Captured on a Remidio smartphone fundus camera
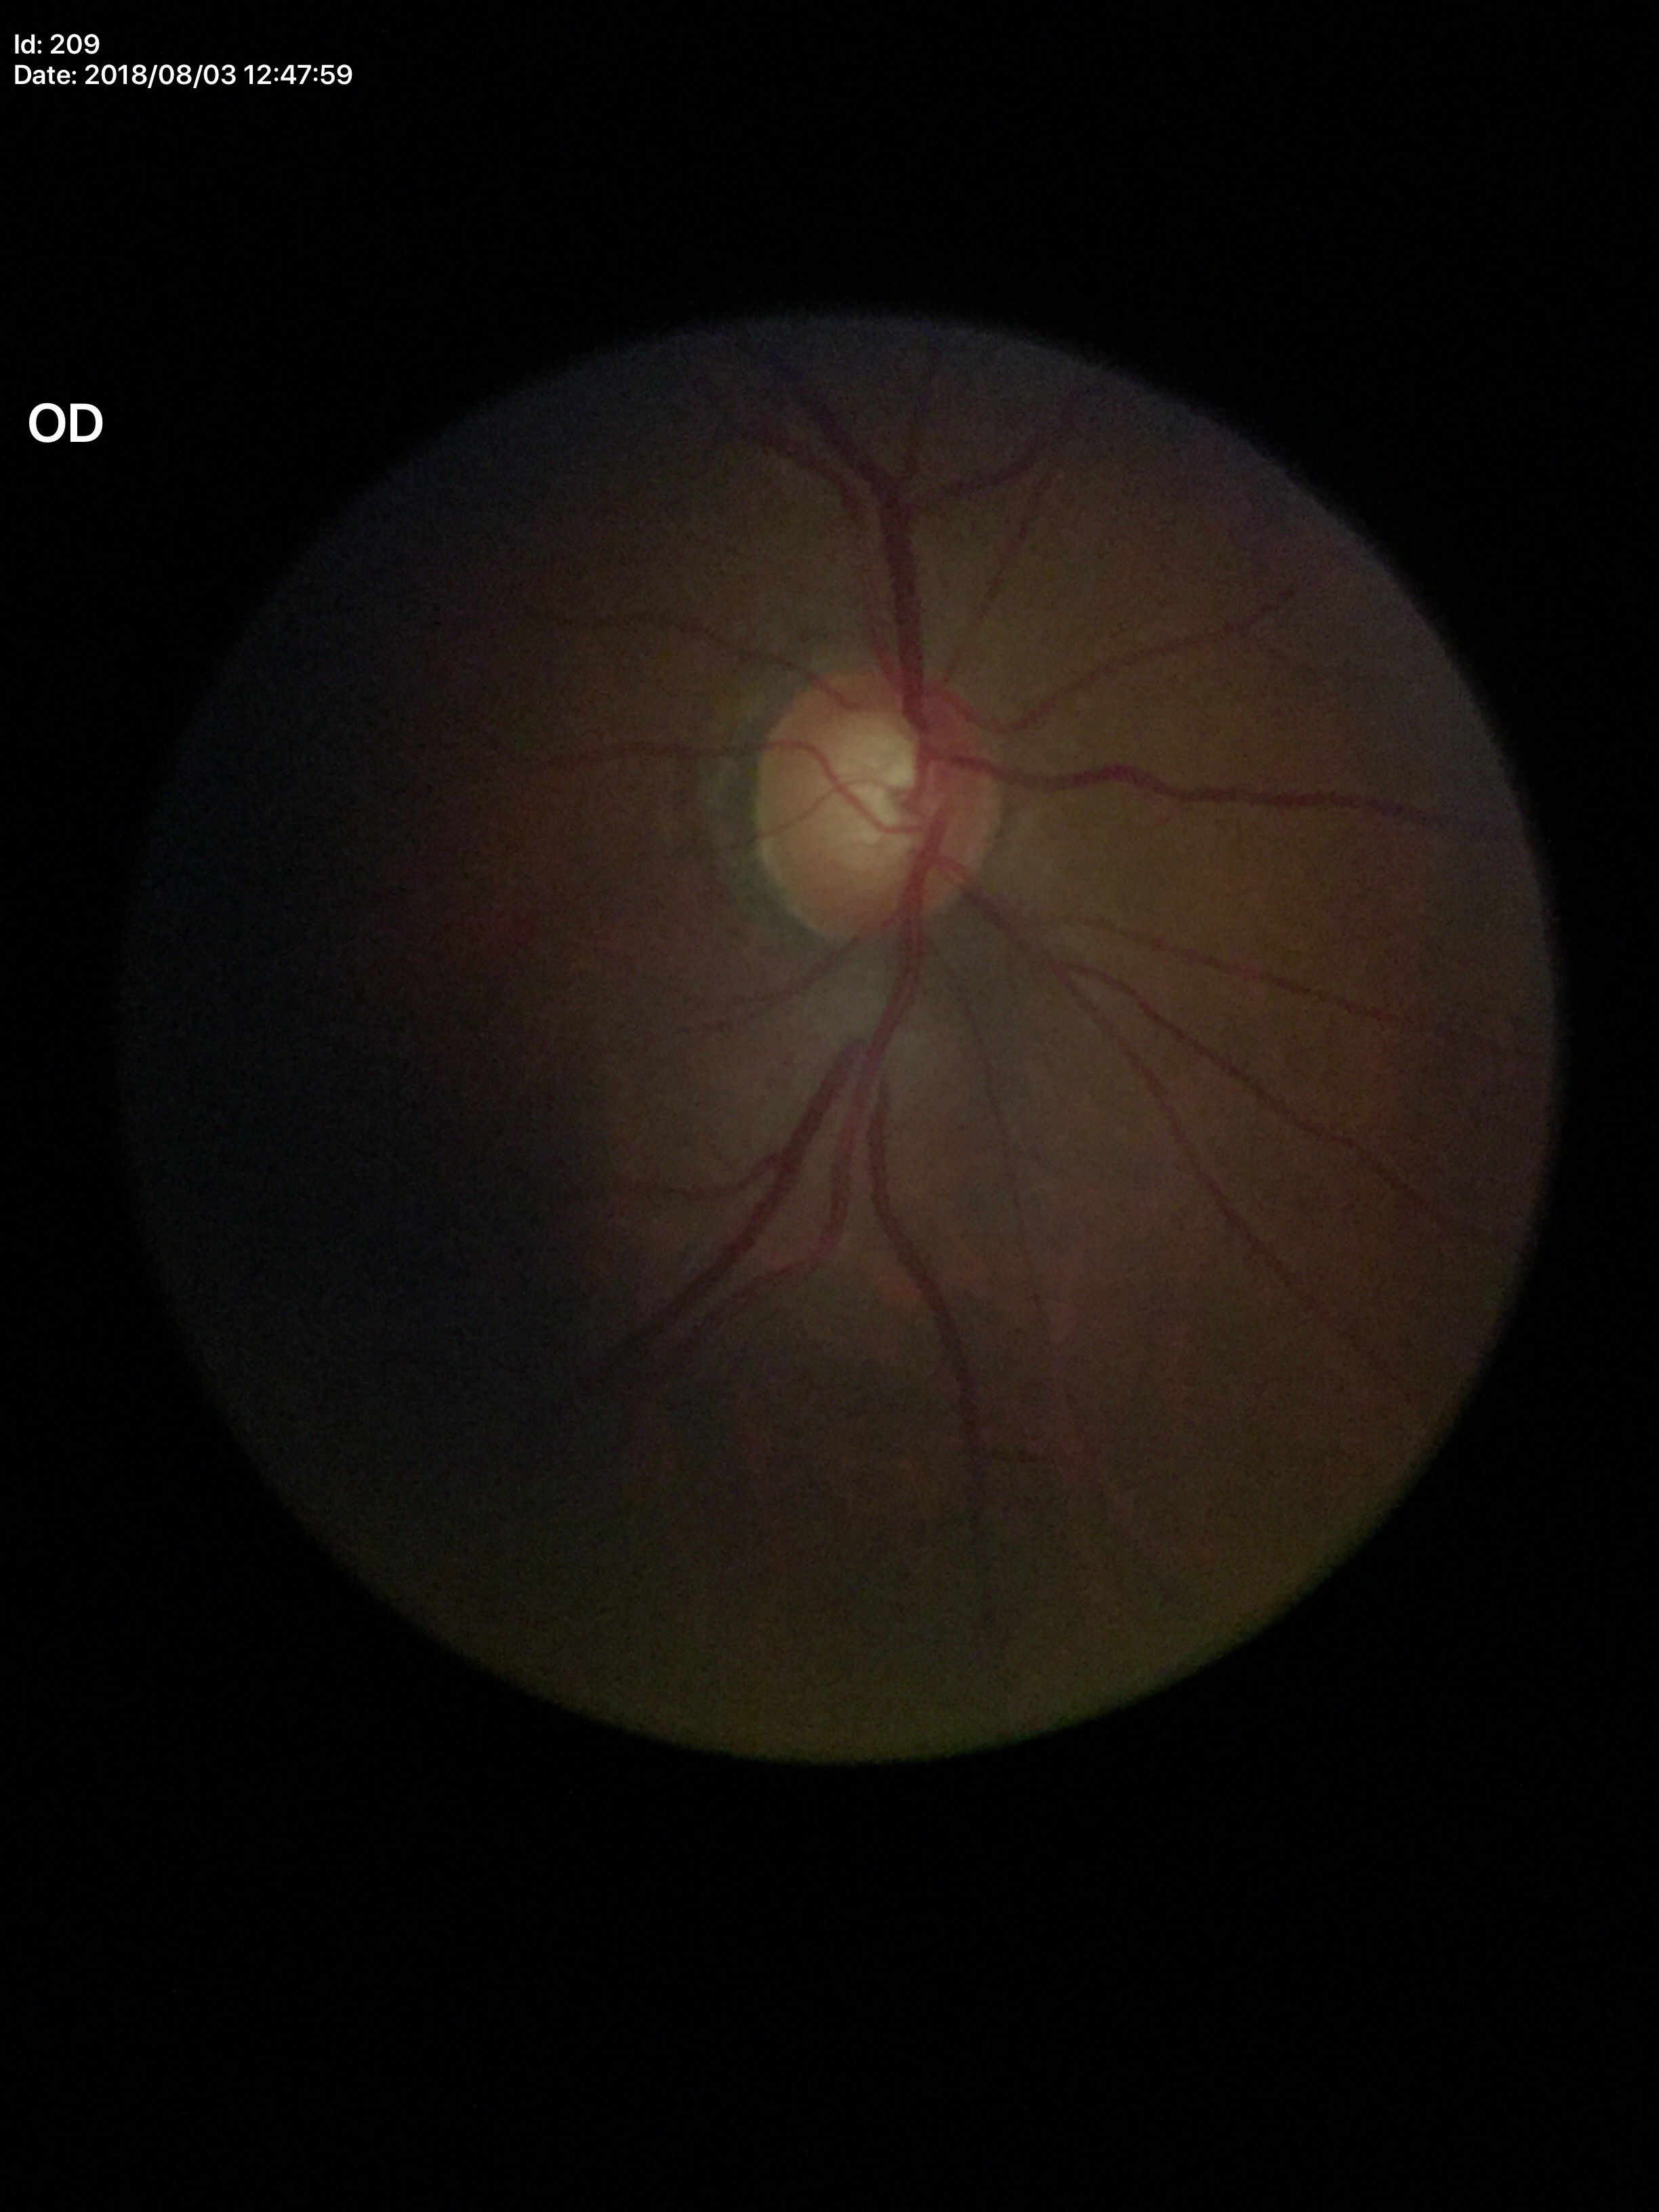

Vertical cup-disc ratio (VCDR): 0.62.
No glaucomatous findings.